Image size 412x310. CFP — 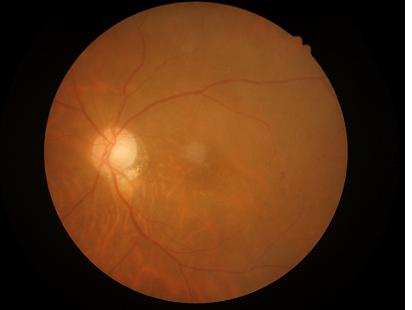
Acceptable image quality. Even illumination with no color cast. Noticeable blur in the optic disc, vessels, or background.